Modified Davis grading: 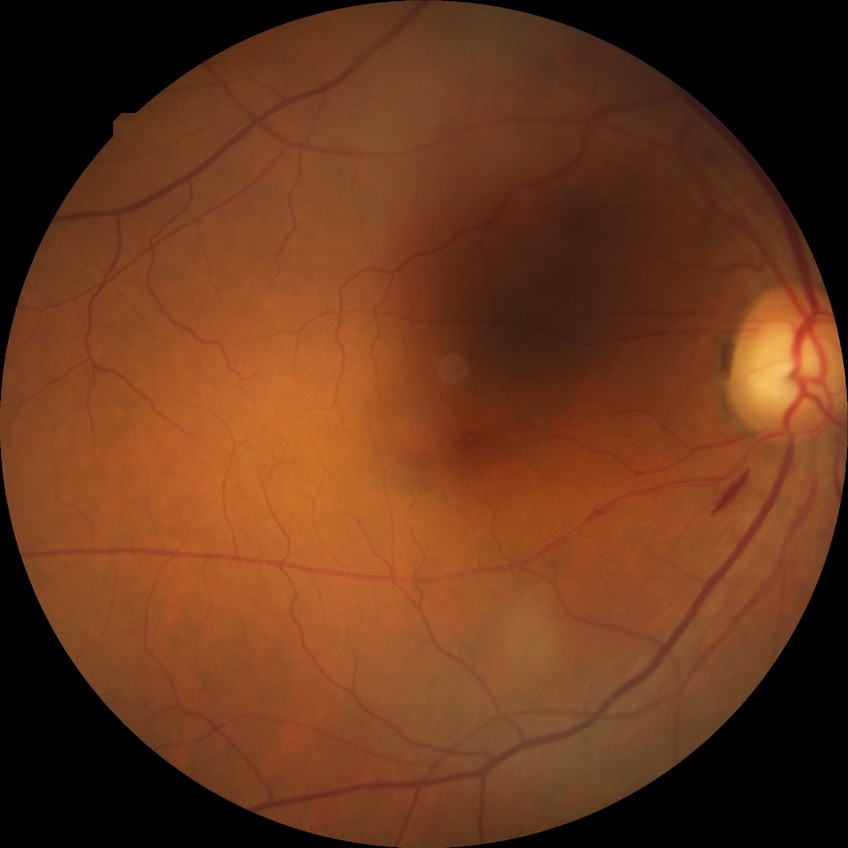 Retinopathy stage is simple diabetic retinopathy.